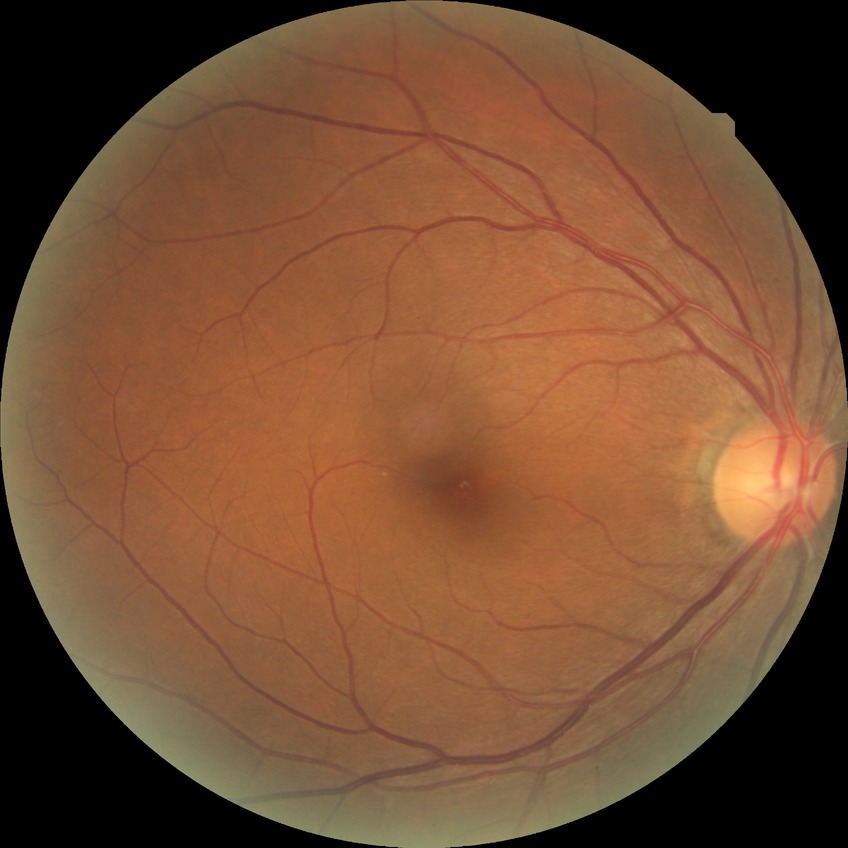
Retinopathy stage is no diabetic retinopathy.